Acquired with a Topcon TRC-NW400 · 30° FOV · age 55.
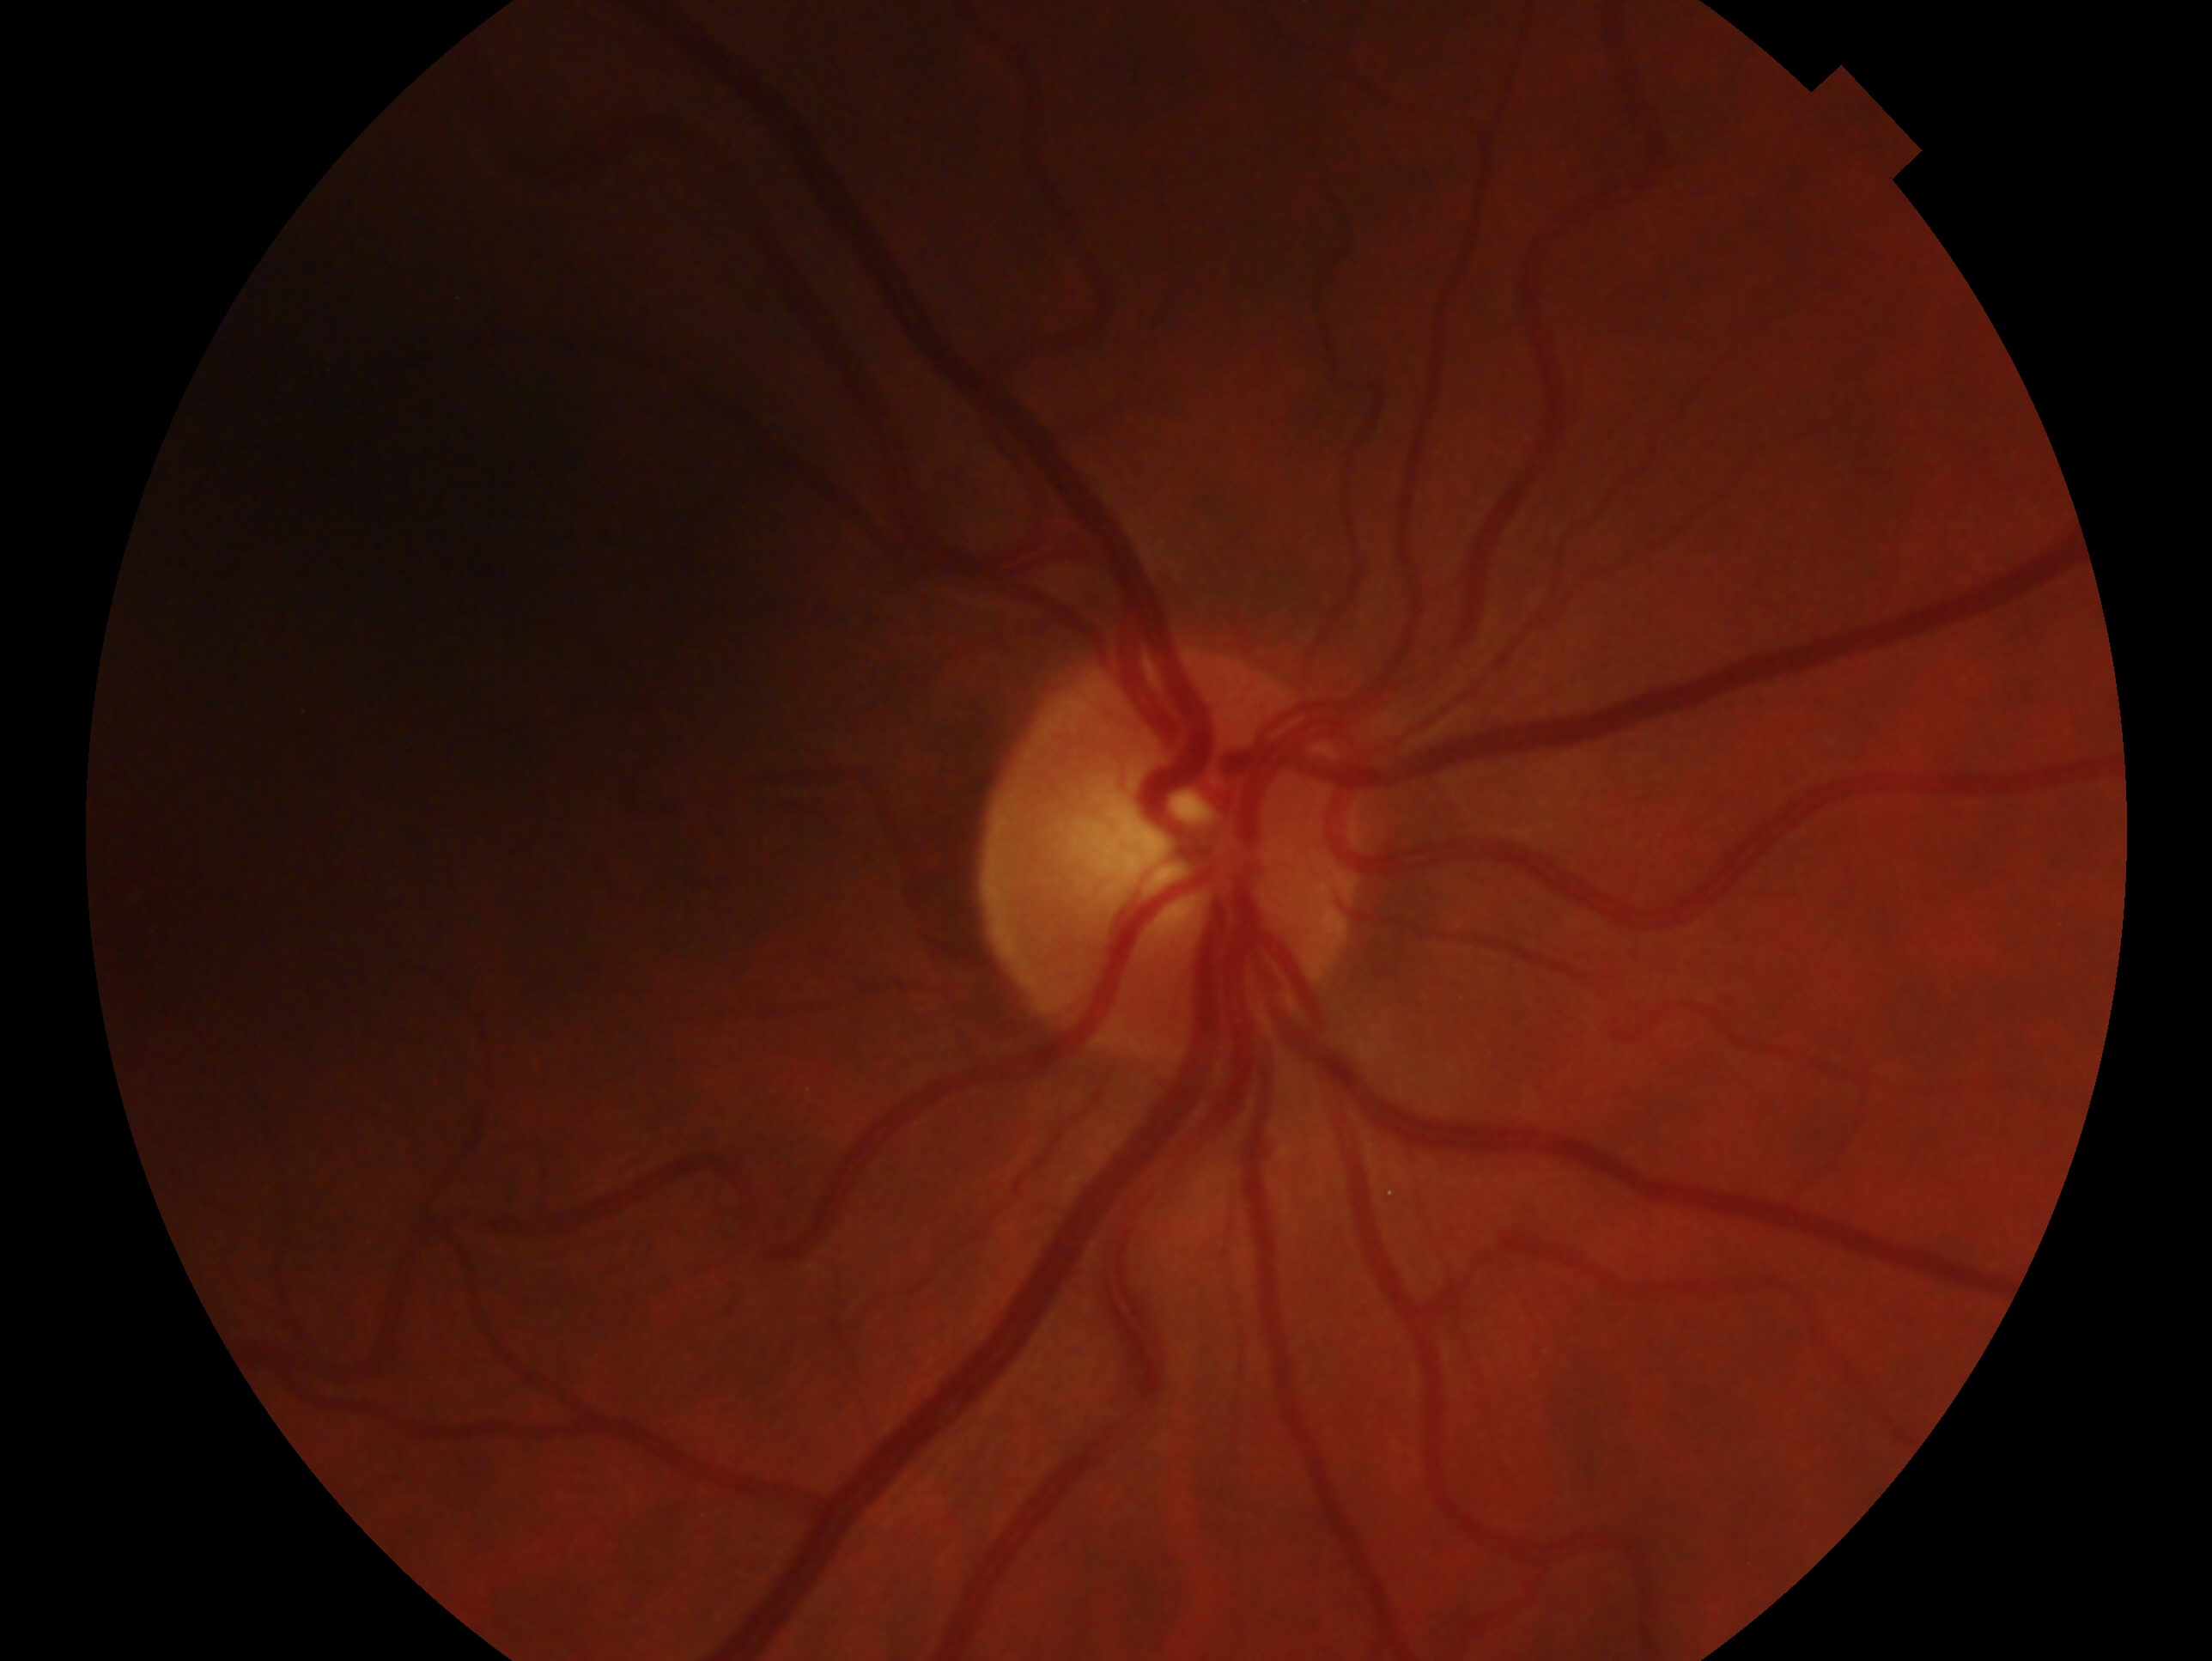 assessment = no evidence of glaucoma | laterality = right.